Infant wide-field retinal image: 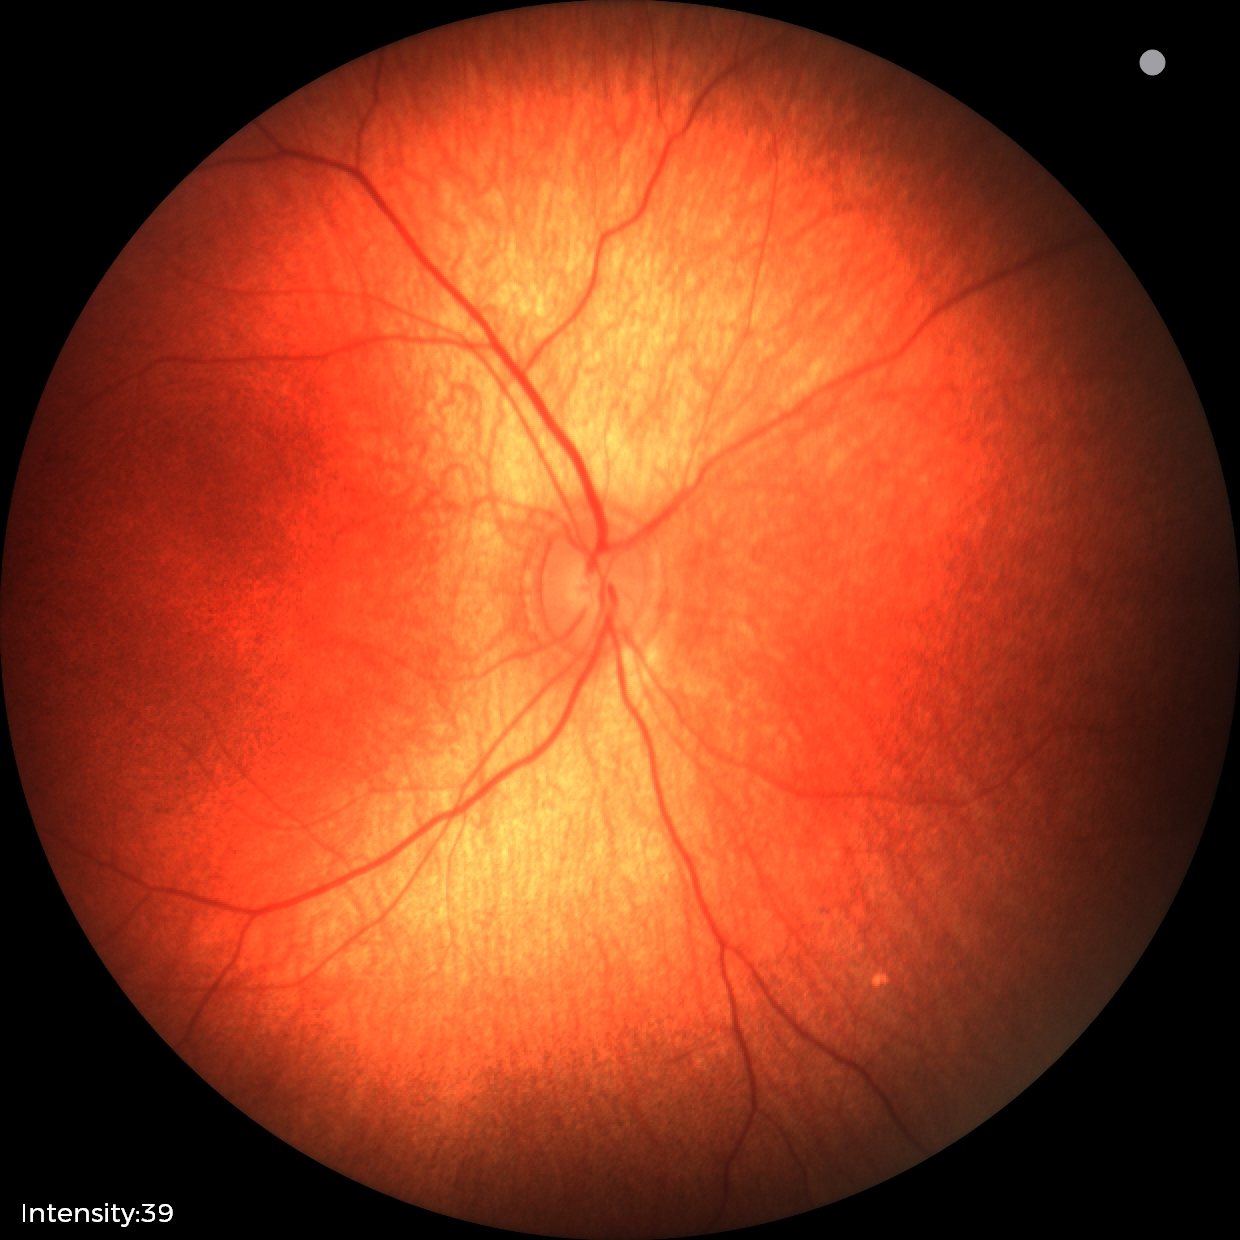 Q: What was the screening finding?
A: physiological retinal finding